Diabetic retinopathy graded by the modified Davis classification: 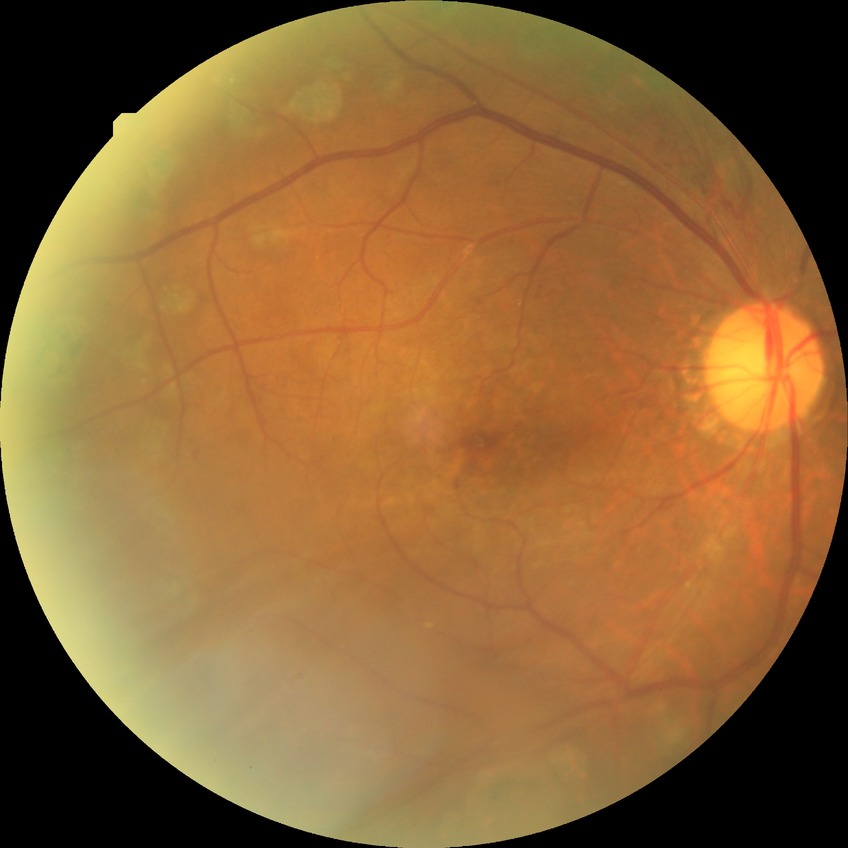

Davis grading=proliferative diabetic retinopathy.